1932 by 1932 pixels; 45° FOV; fundus photo
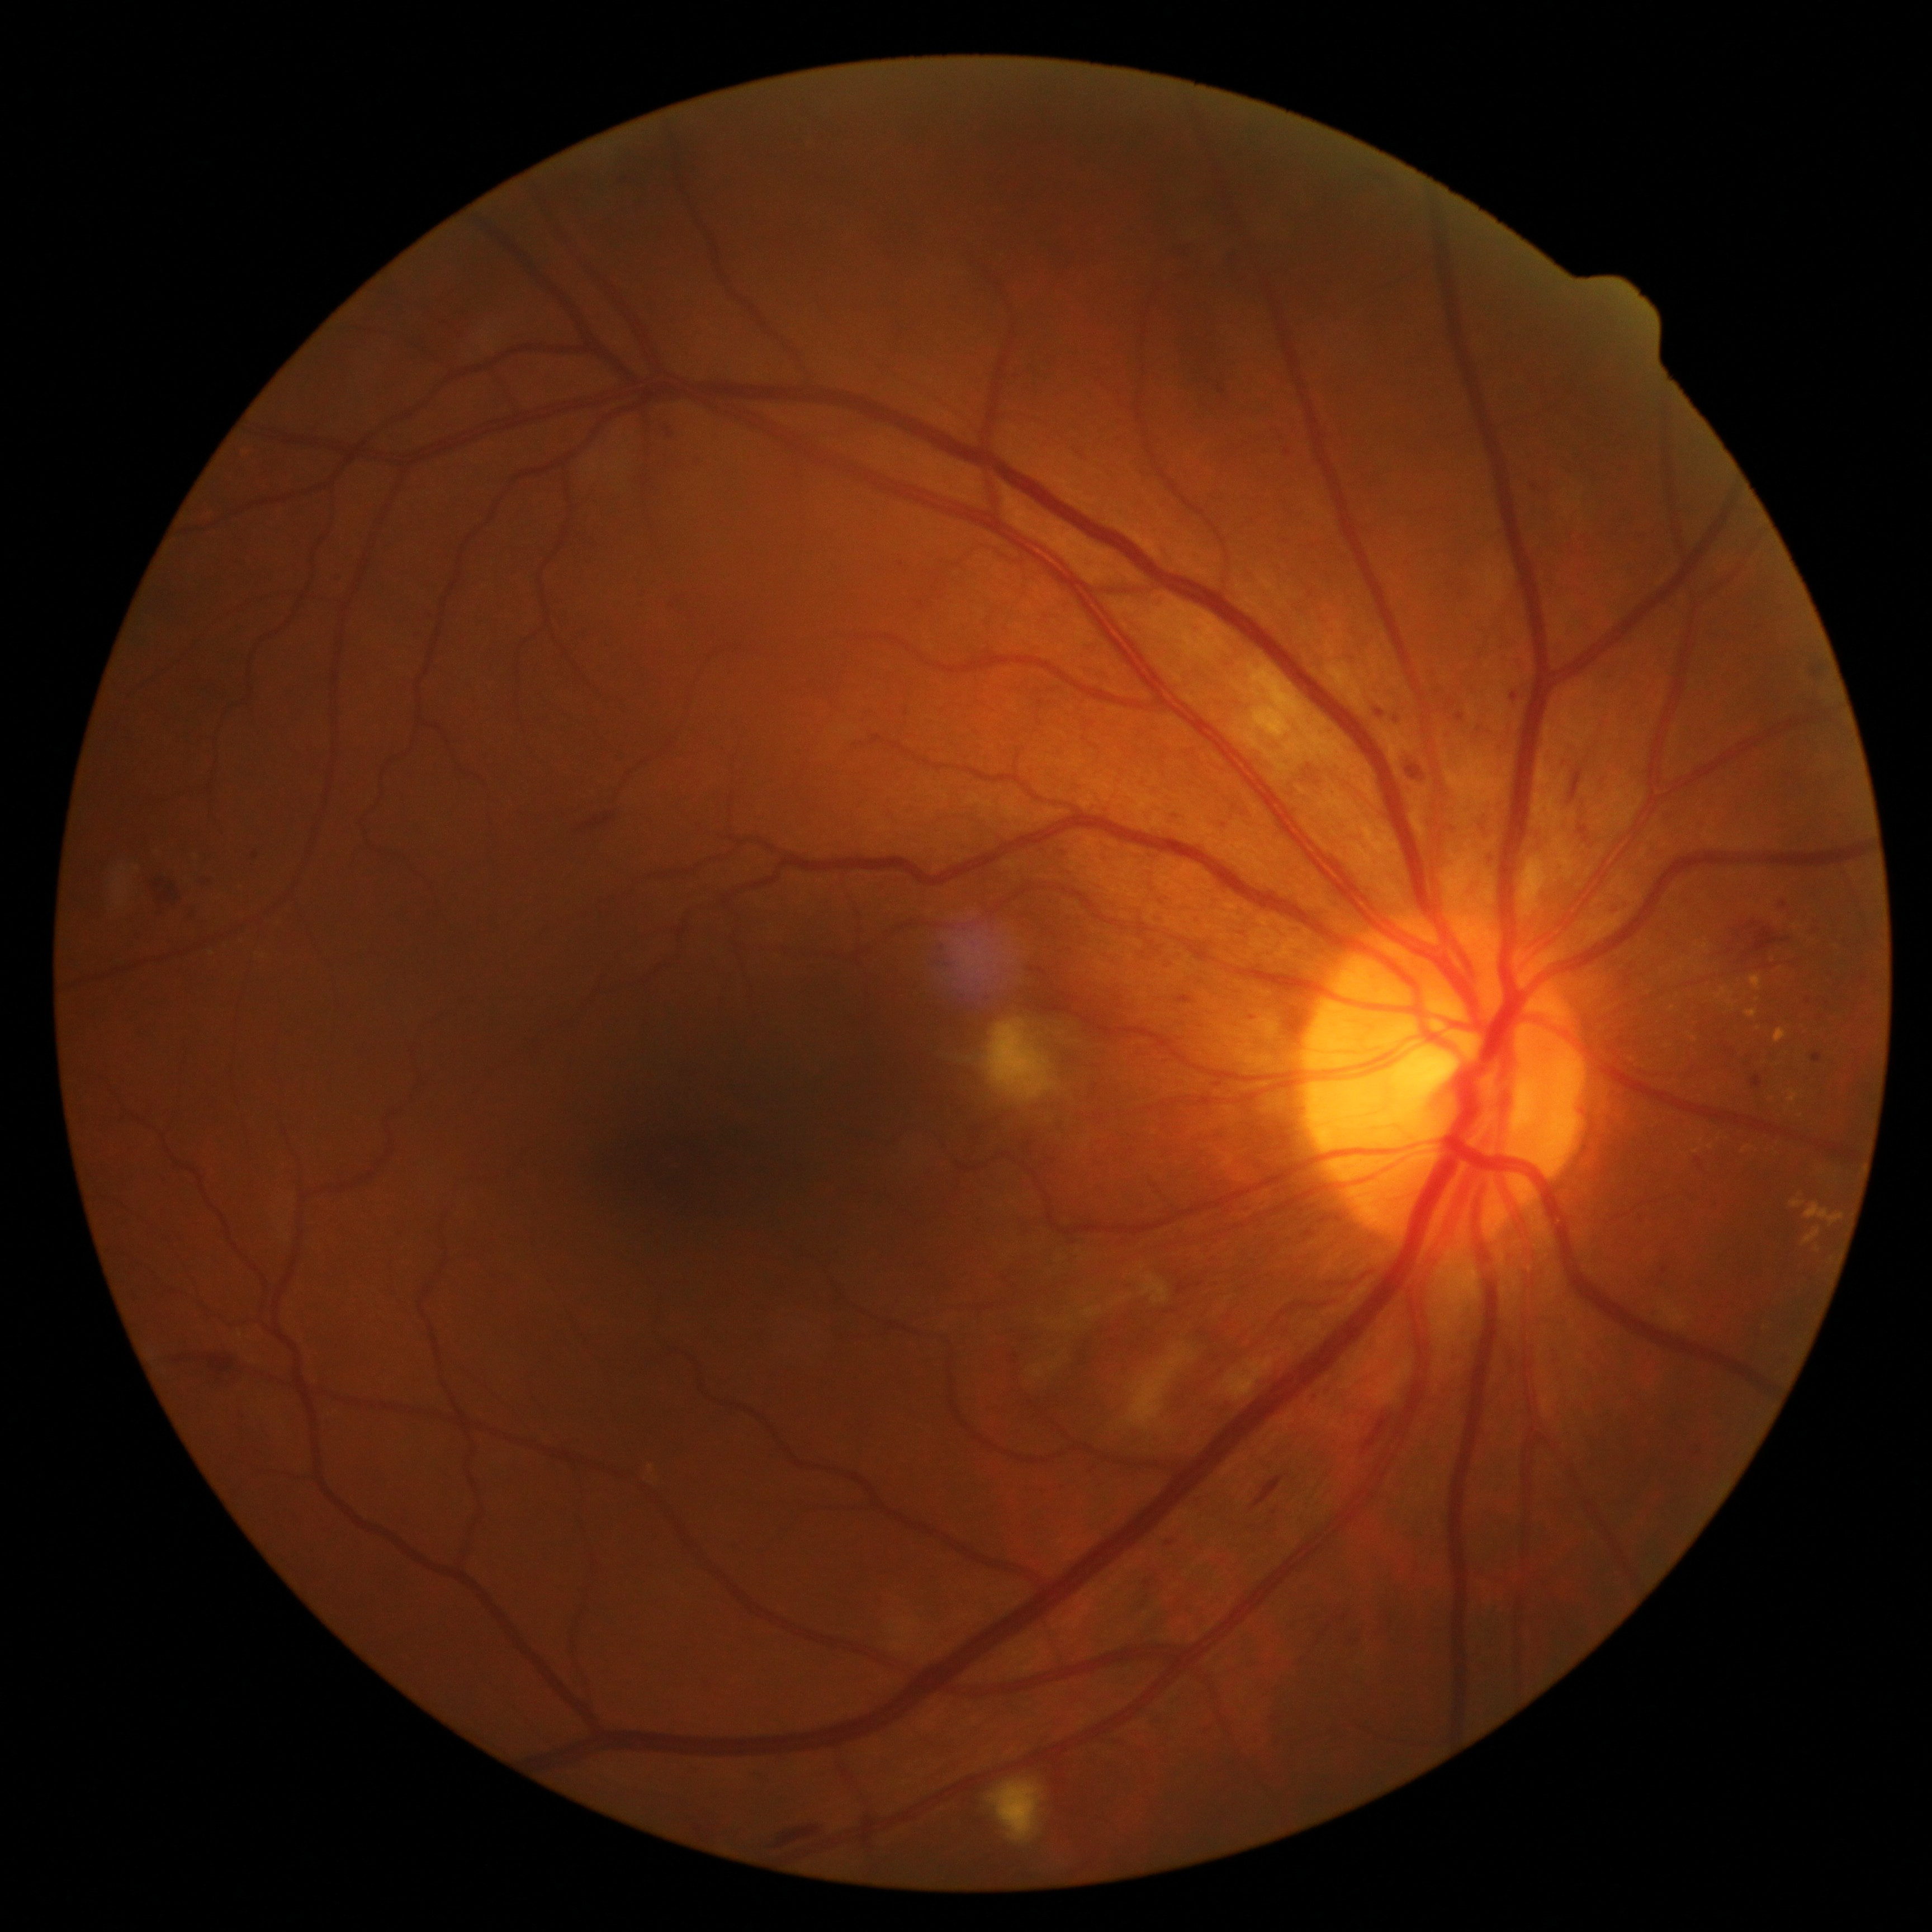
DR severity is moderate non-proliferative diabetic retinopathy (grade 2).